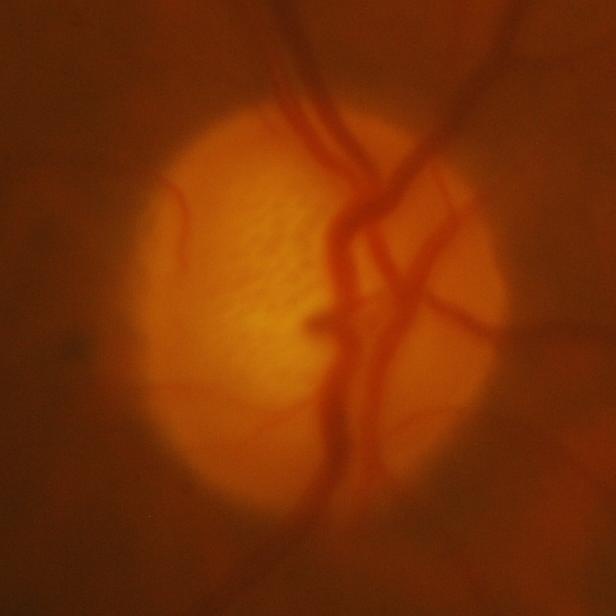

Glaucomatous changes are present. Disc-centered fundus crop showing glaucomatous damage to the optic nerve.